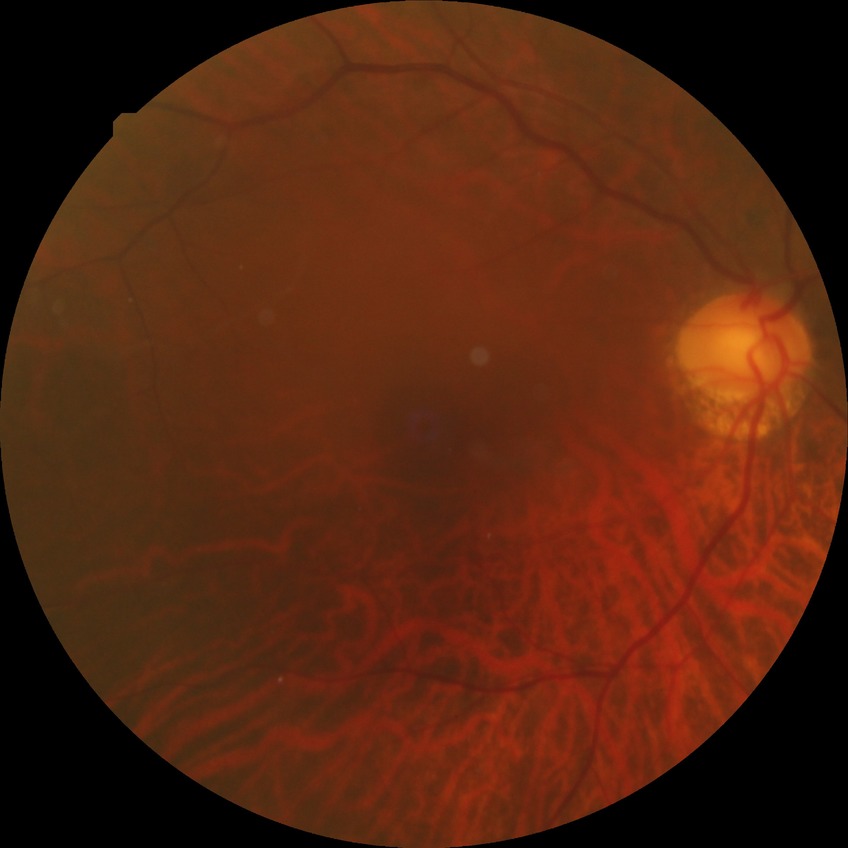

DR stage is NDR. No diabetic retinal disease findings.